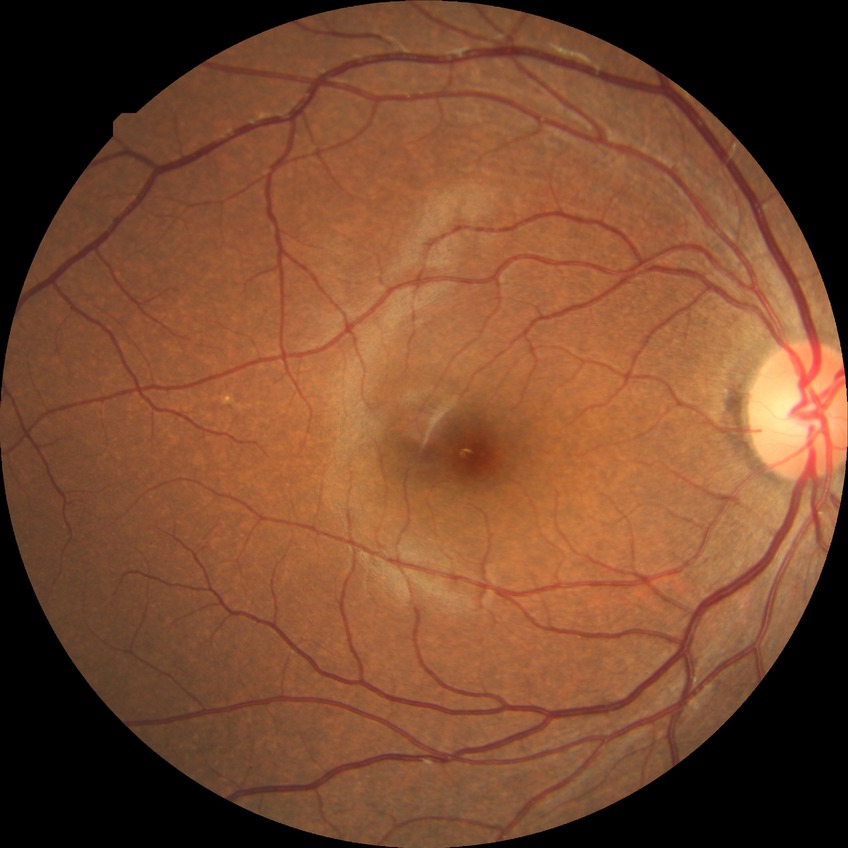 Modified Davis grading is no diabetic retinopathy.